Color fundus photograph
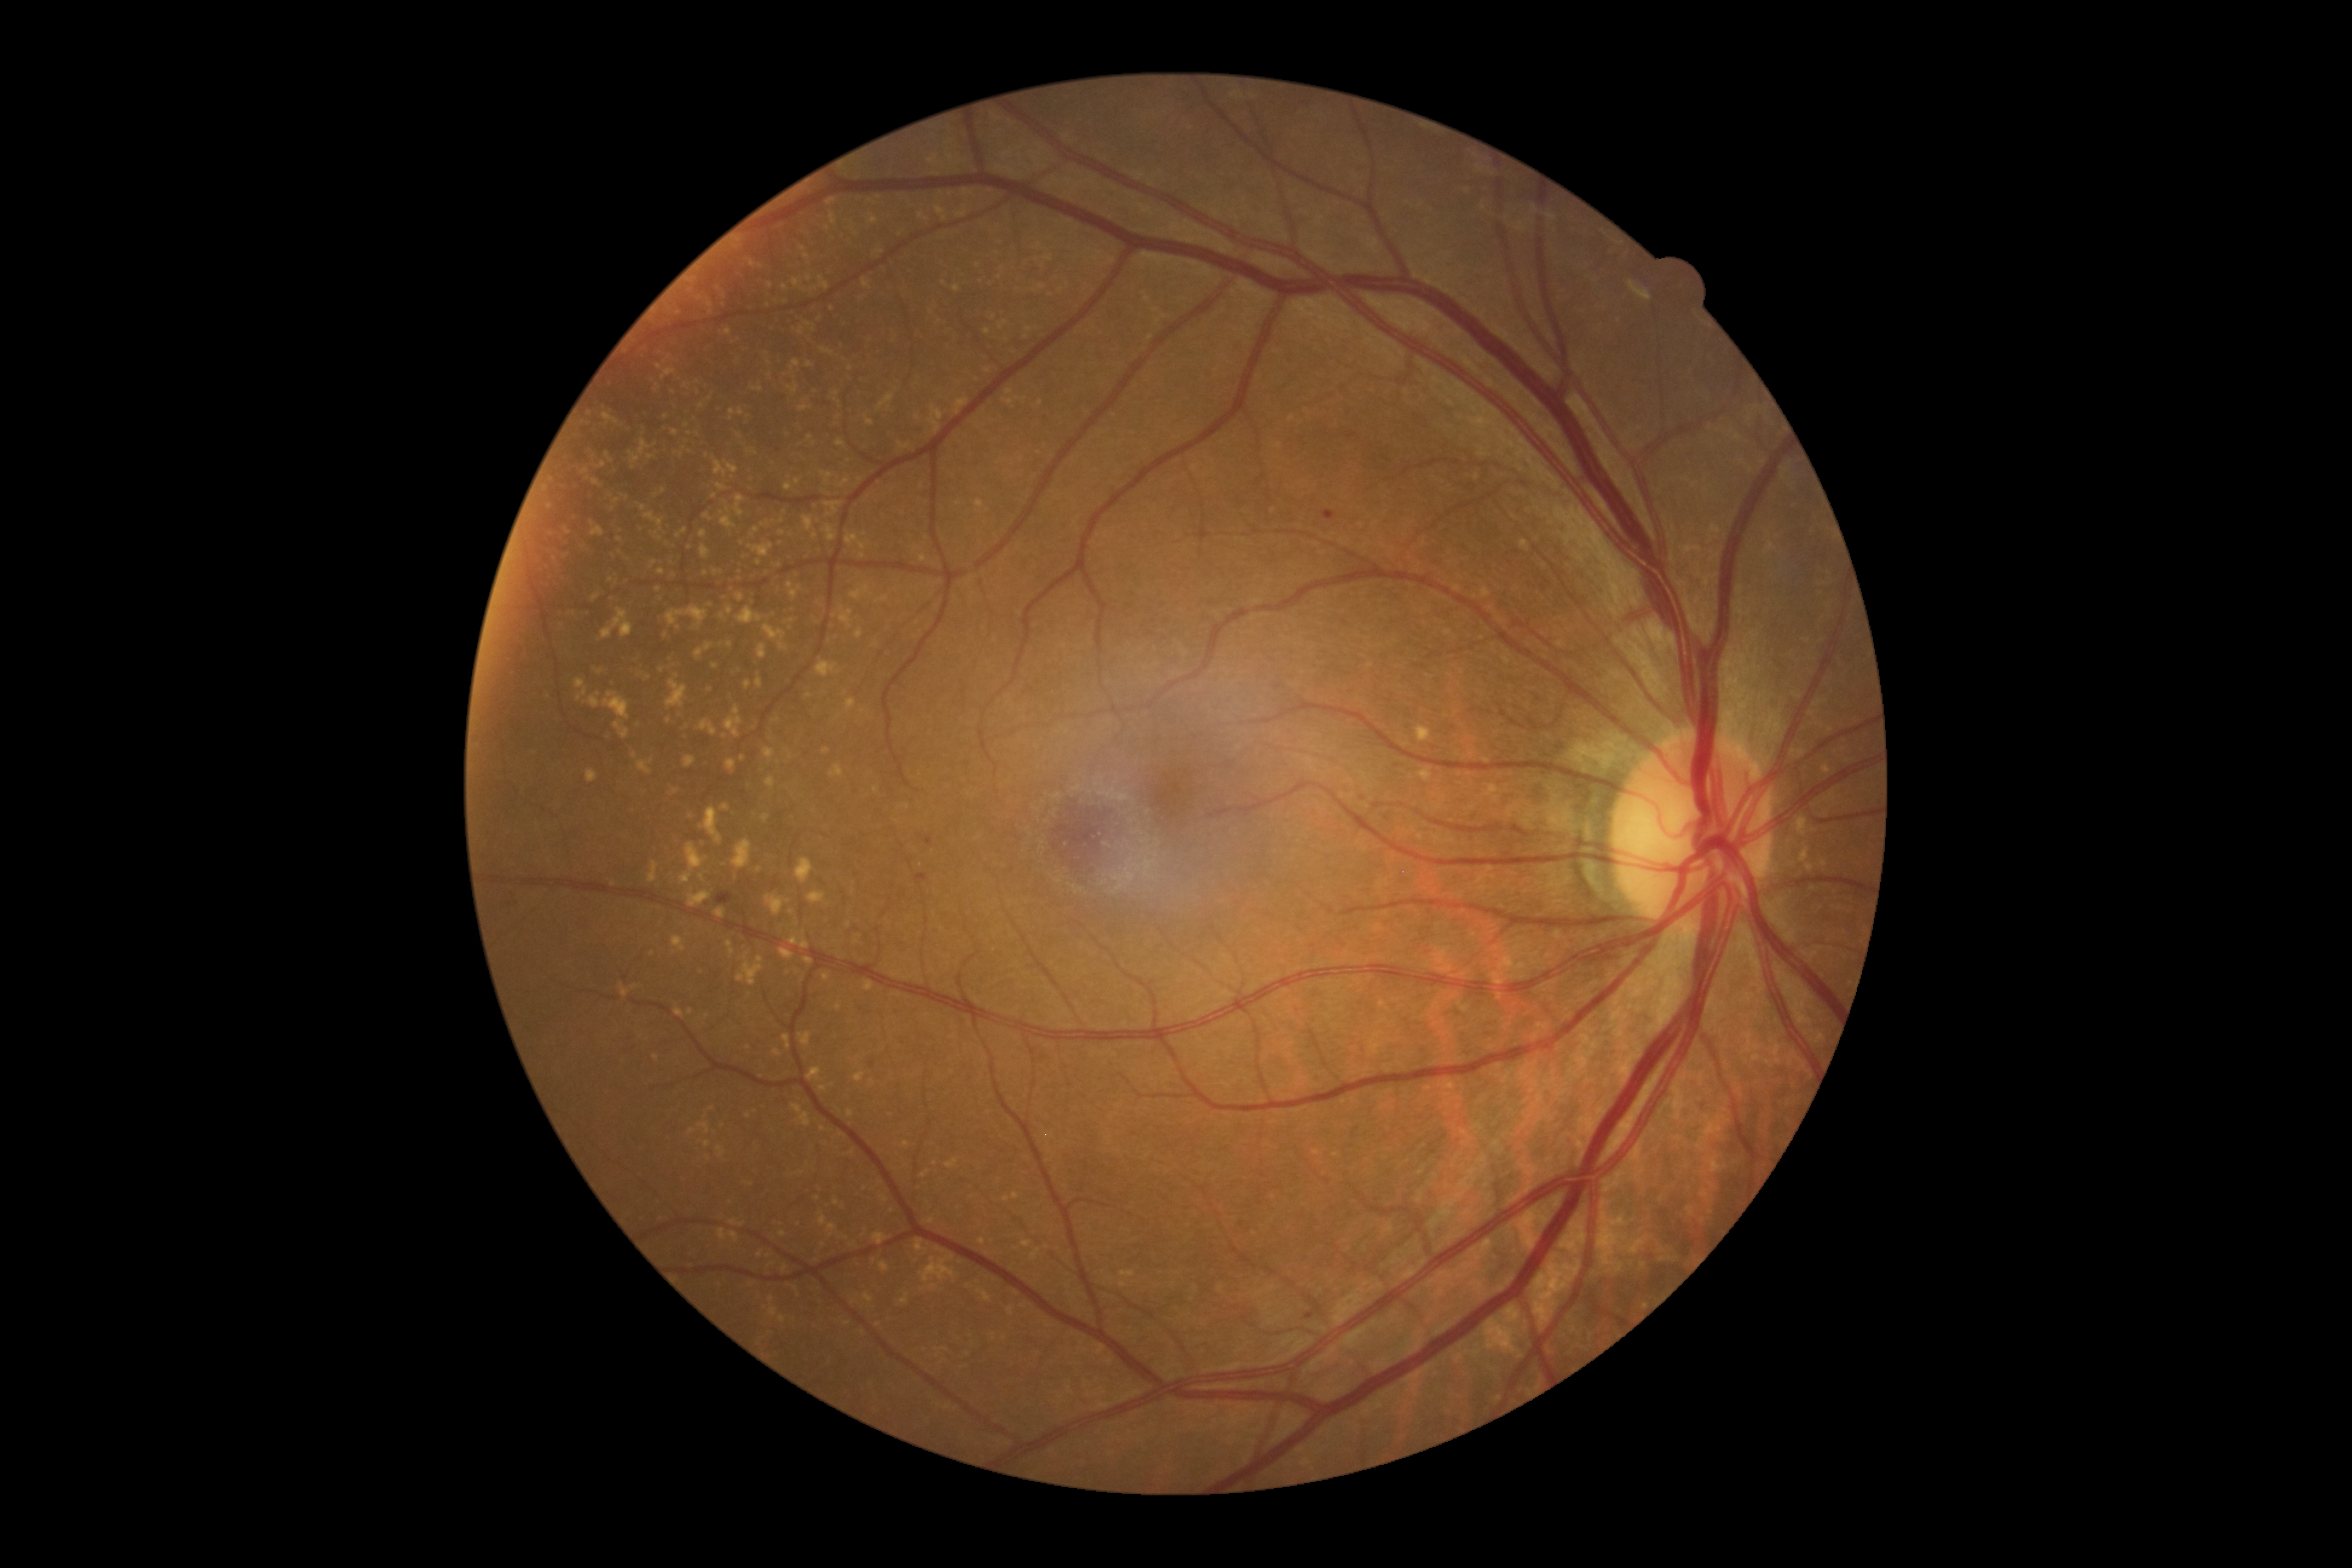
Diabetic retinopathy severity: moderate NPDR (grade 2).